No pharmacologic dilation
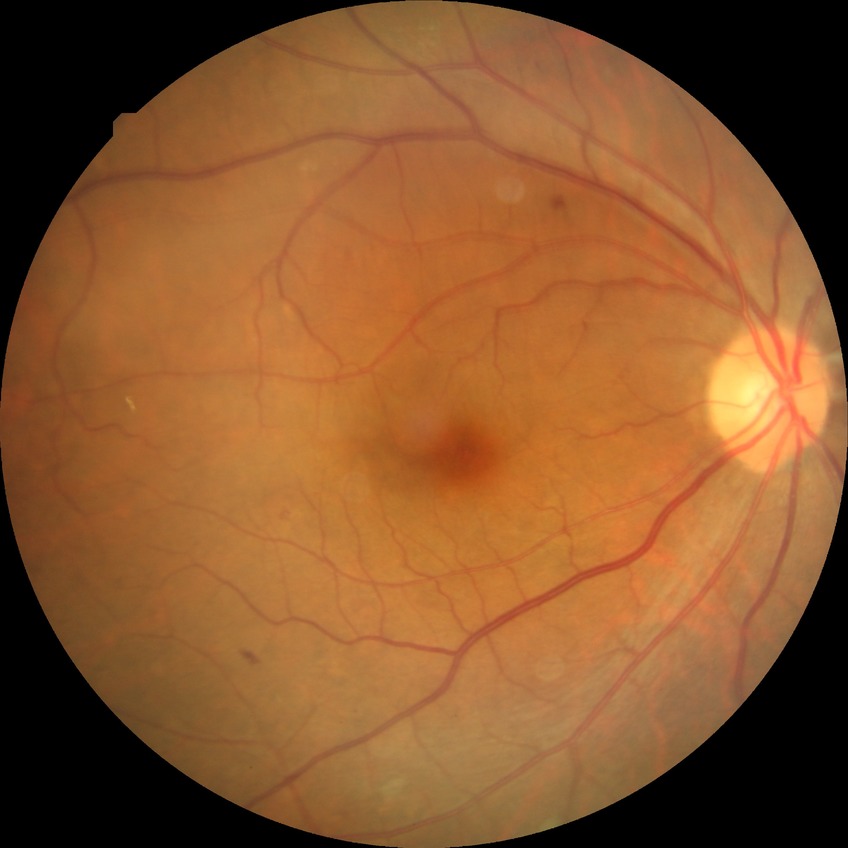
Diabetic retinopathy grade is simple diabetic retinopathy.